Color fundus photograph.
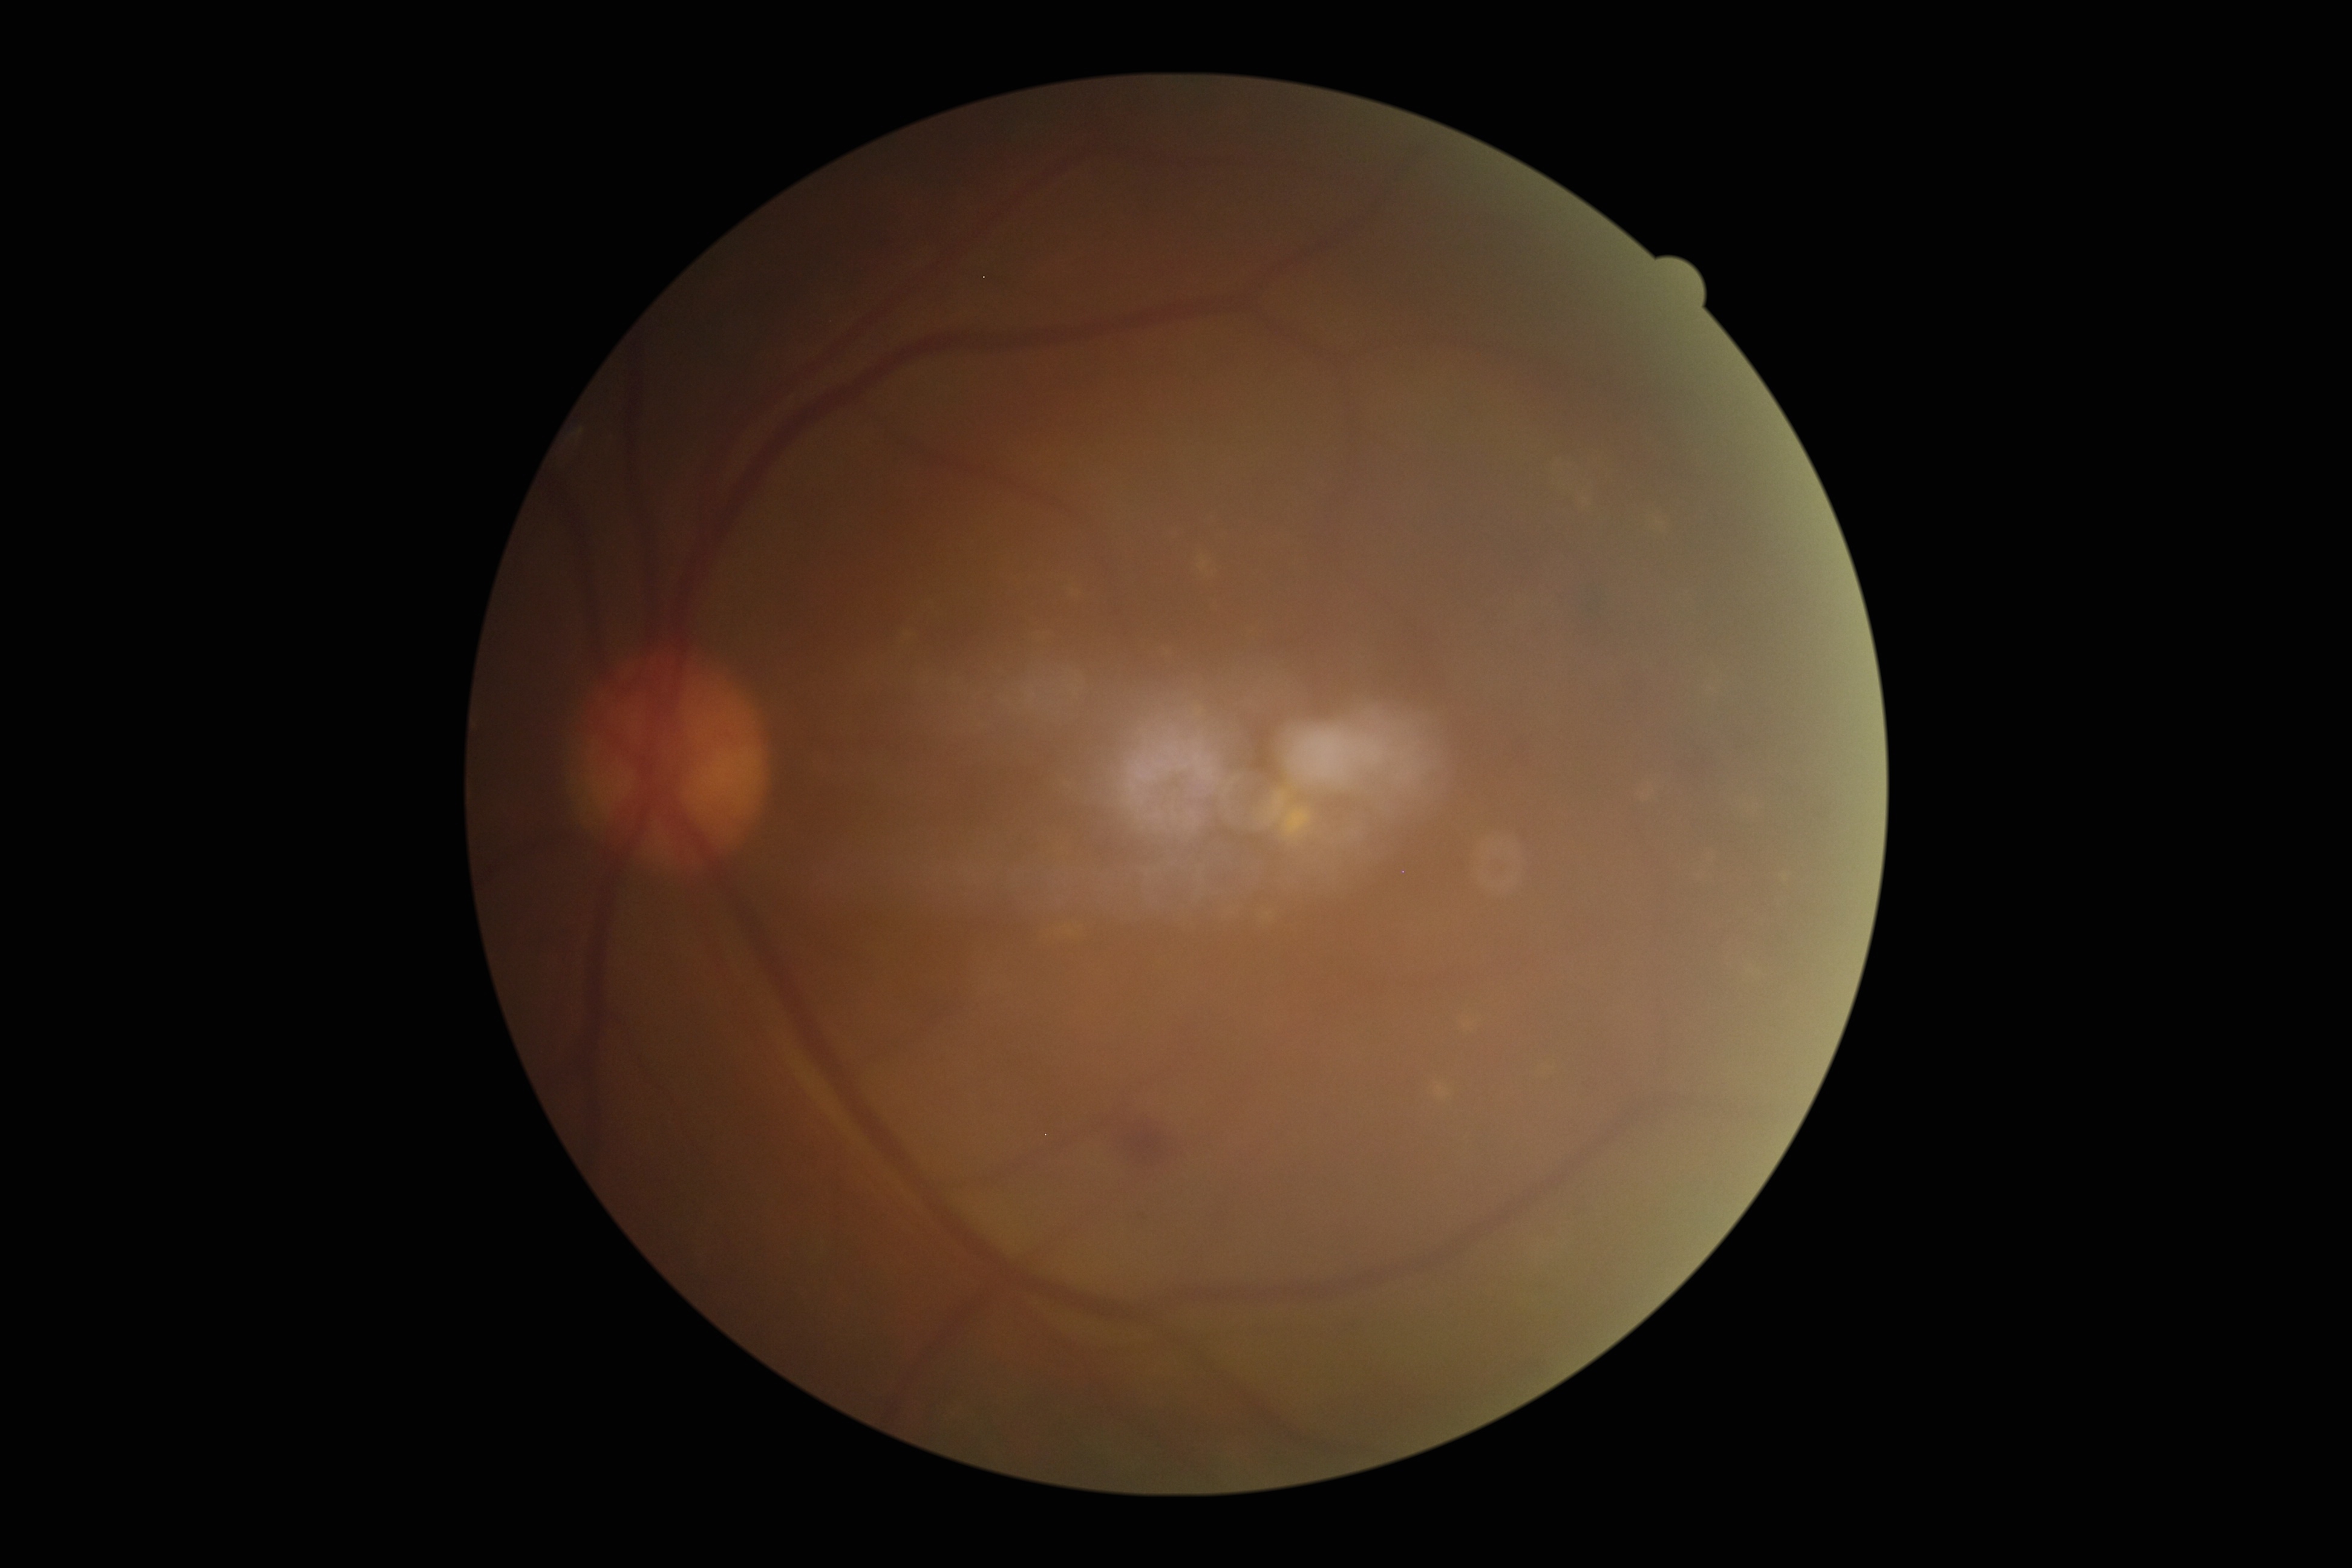
Diabetic retinopathy (DR): grade 2 (moderate NPDR).